Fundus photo. 45-degree field of view. Nonmydriatic. 848x848px. NIDEK AFC-230.
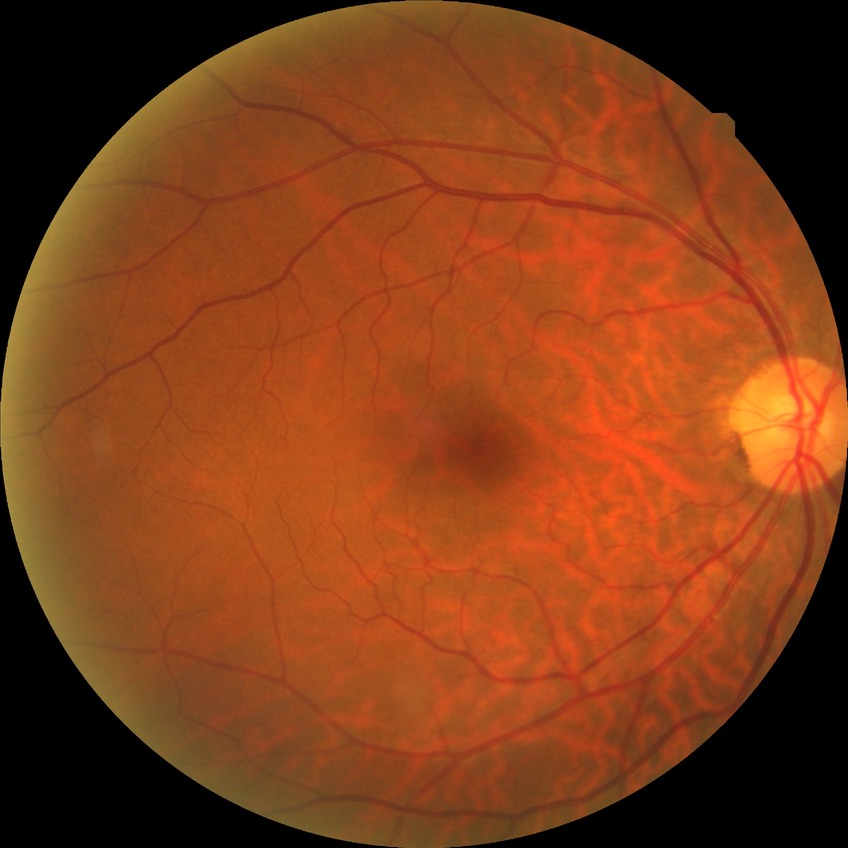 Diabetic retinopathy (DR): NDR (no diabetic retinopathy).